Acquired with a NIDEK AFC-230; FOV: 45 degrees; retinal fundus photograph:
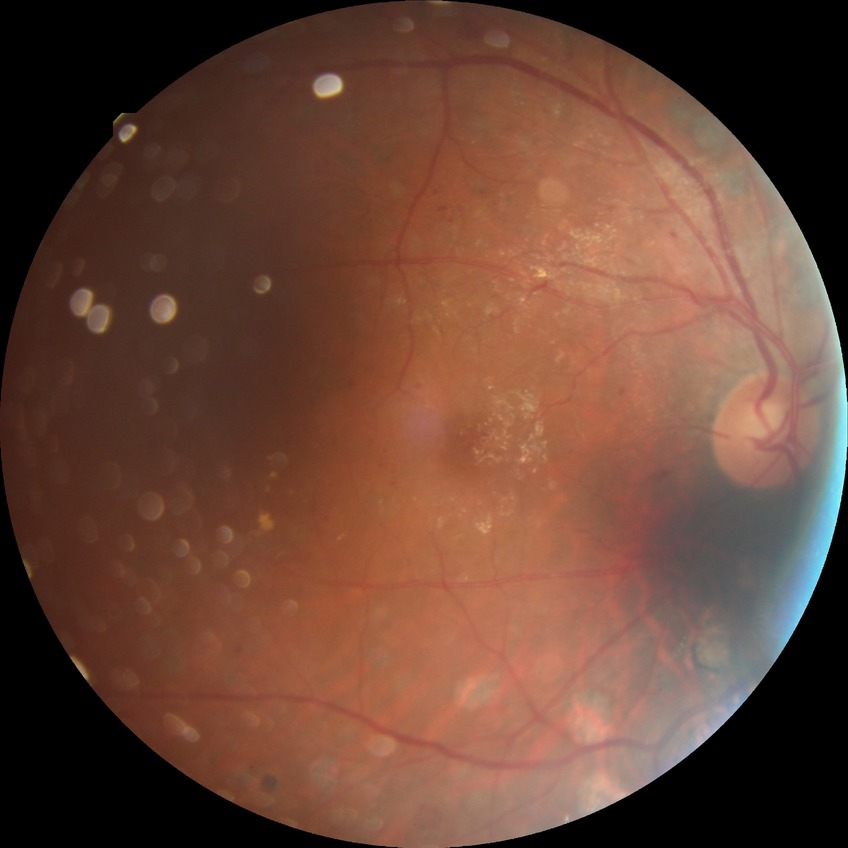

Retinopathy grade: proliferative diabetic retinopathy.